Davis DR grading
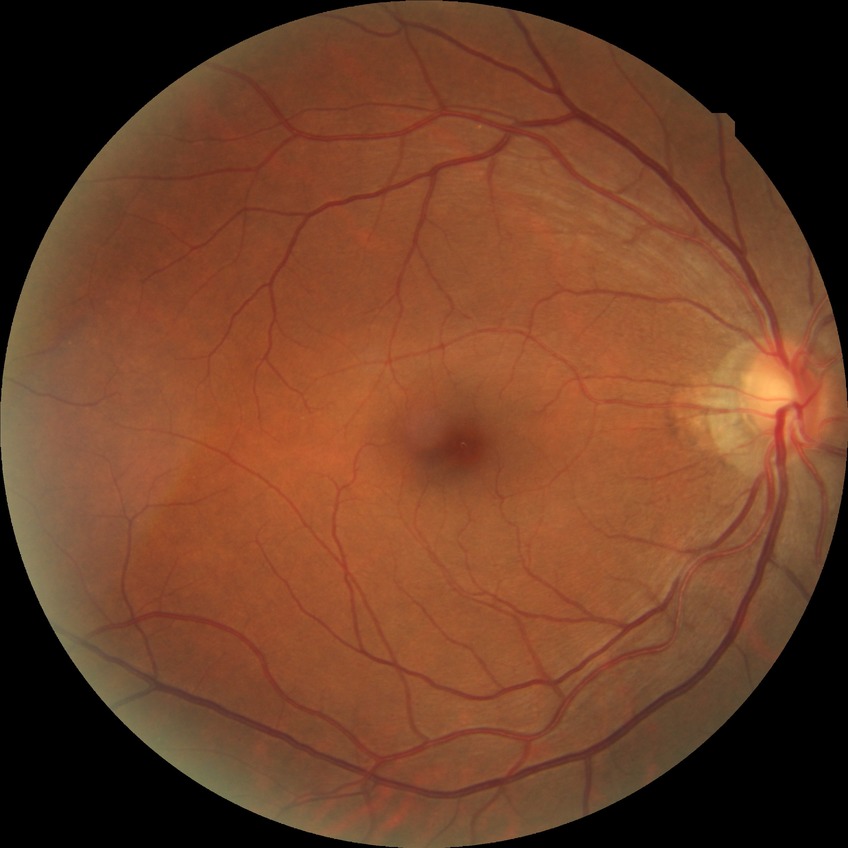 {"davis_grade": "NDR"}